FOV: 45 degrees
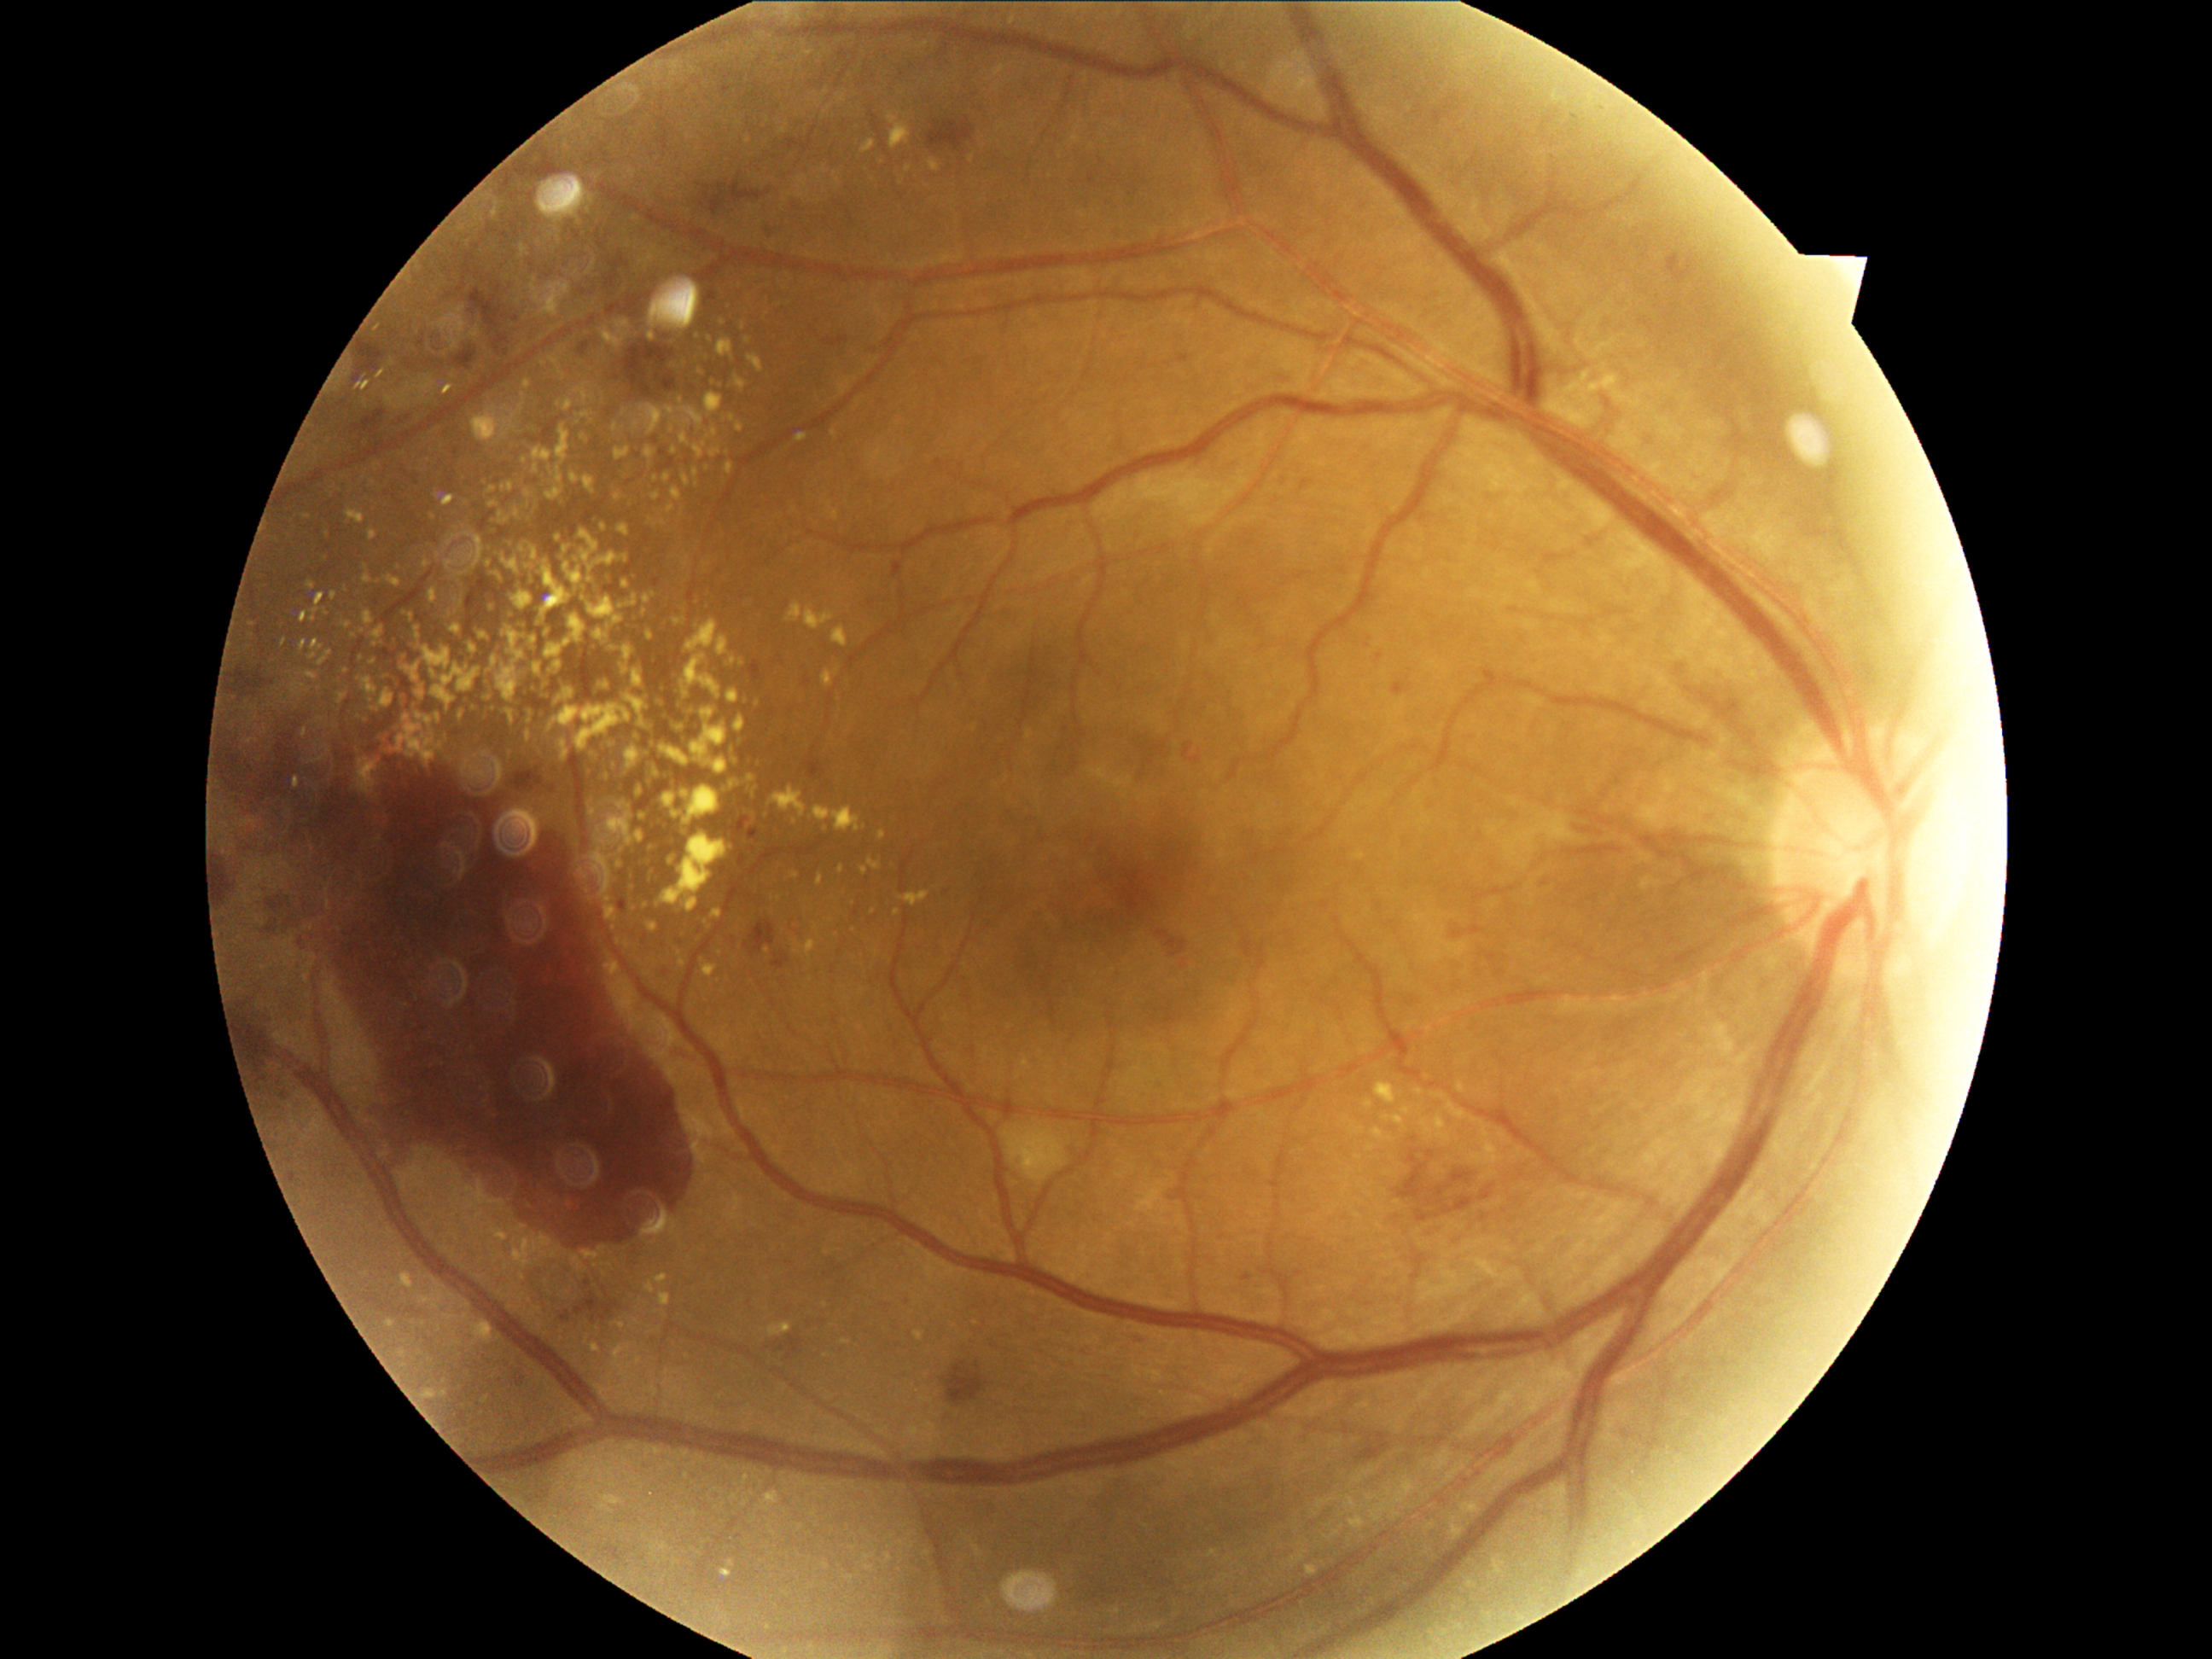
Diabetic retinopathy grade is 4 (PDR)
A subset of detected lesions:
hard exudates (subset): (656, 793, 677, 810) | (694, 445, 706, 458) | (588, 648, 597, 660) | (1351, 1515, 1365, 1532) | (509, 615, 518, 622) | (535, 561, 573, 627) | (422, 648, 450, 670) | (1365, 1102, 1373, 1109) | (680, 433, 690, 446) | (527, 733, 532, 742) | (530, 648, 540, 655) | (339, 694, 347, 702)
Small hard exudates approximately at 449, 543 | 675, 451 | 535, 500 | 364, 565 | 593, 813 | 513, 426 | 426, 1301